Color fundus image. 45° field of view:
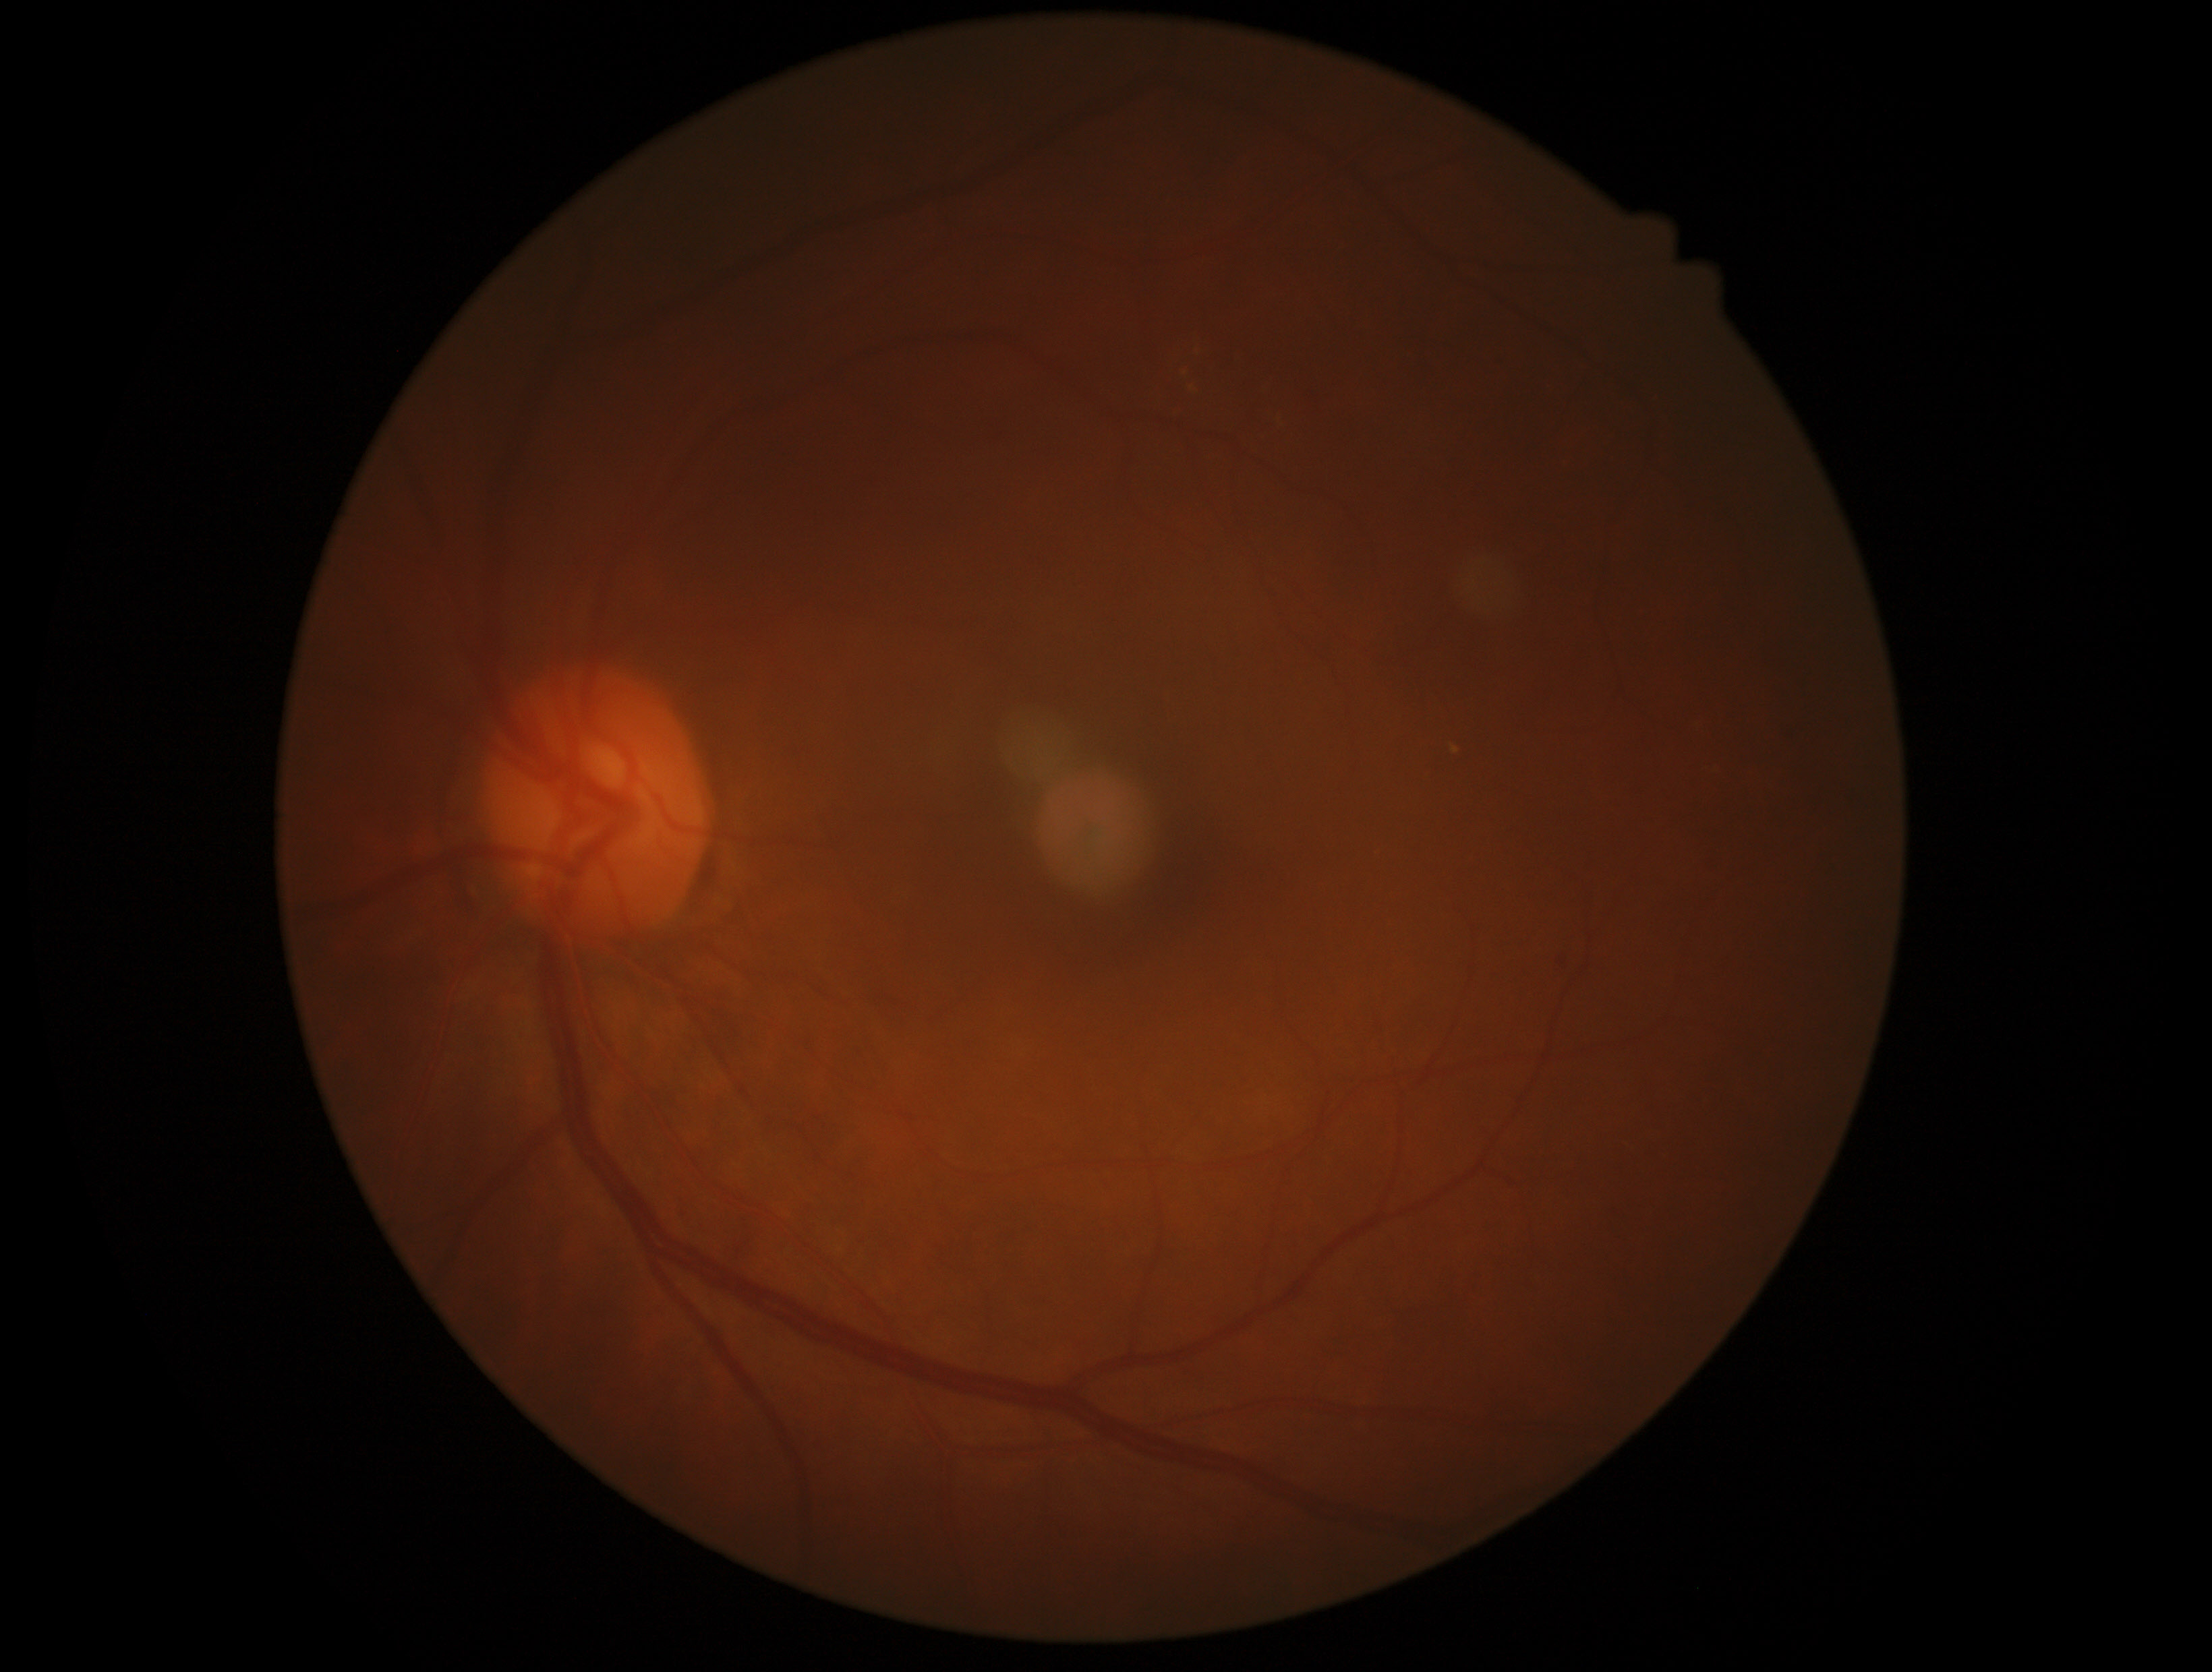 - retinopathy grade — moderate non-proliferative diabetic retinopathy (2)